Camera: Natus RetCam Envision (130° FOV). 1440 x 1080 pixels. Wide-field fundus image from infant ROP screening.
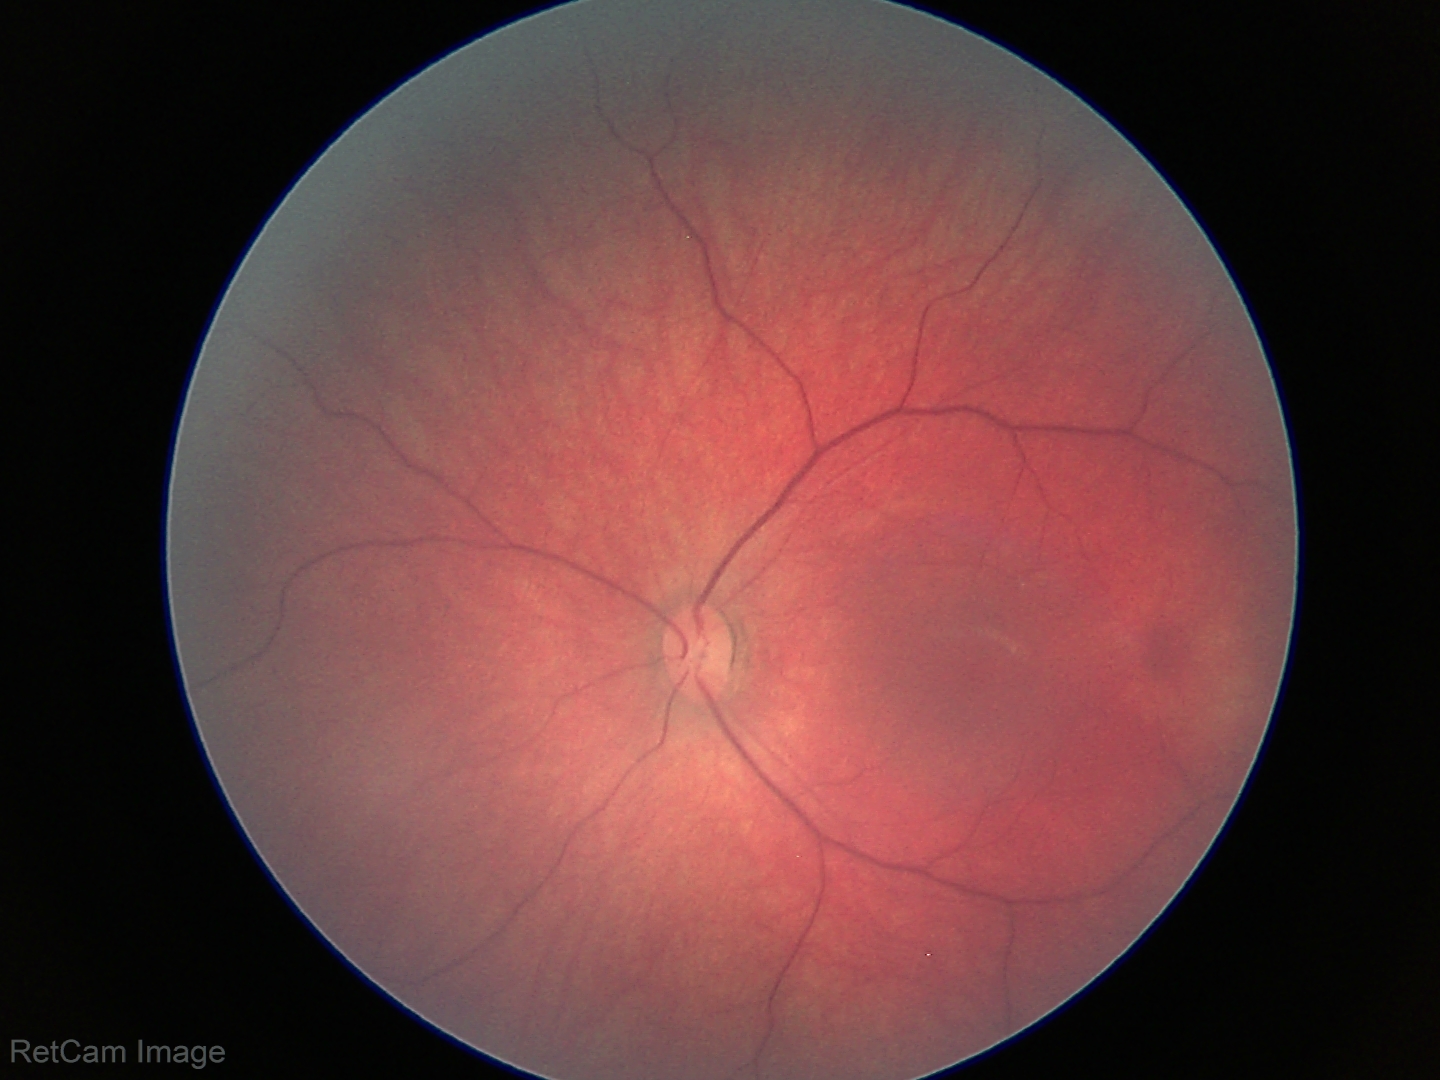 Assessment: physiological retinal finding.